Color fundus photograph · nonmydriatic · 45° field of view · acquired with a NIDEK AFC-230 — 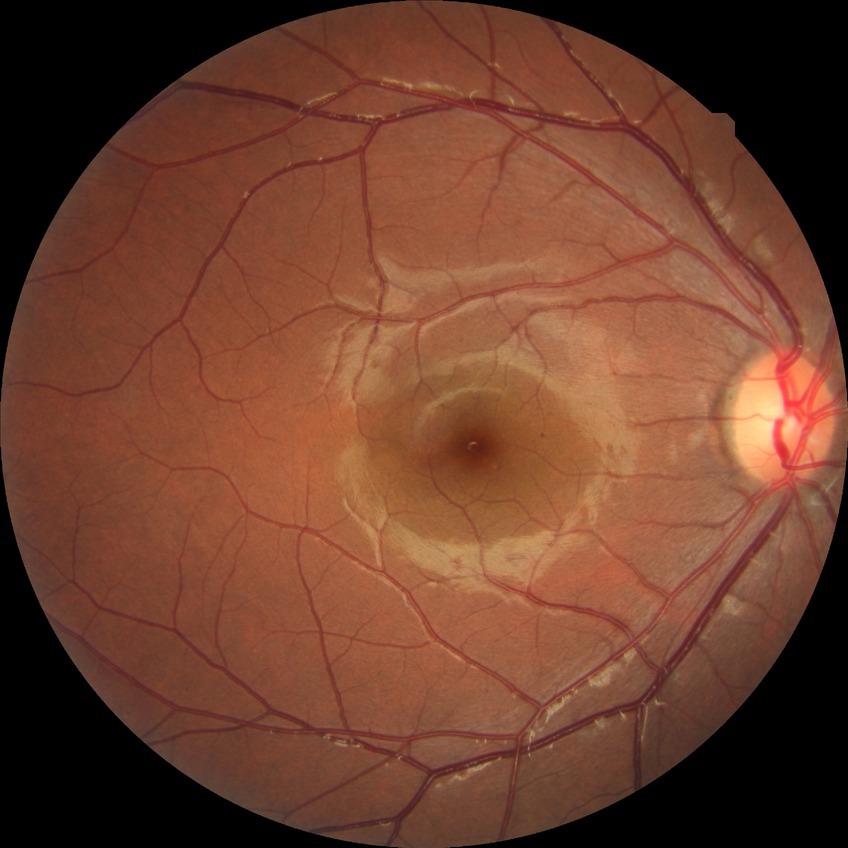
Annotations:
* diabetic retinopathy (DR) — SDR (simple diabetic retinopathy)
* DR class — non-proliferative diabetic retinopathy